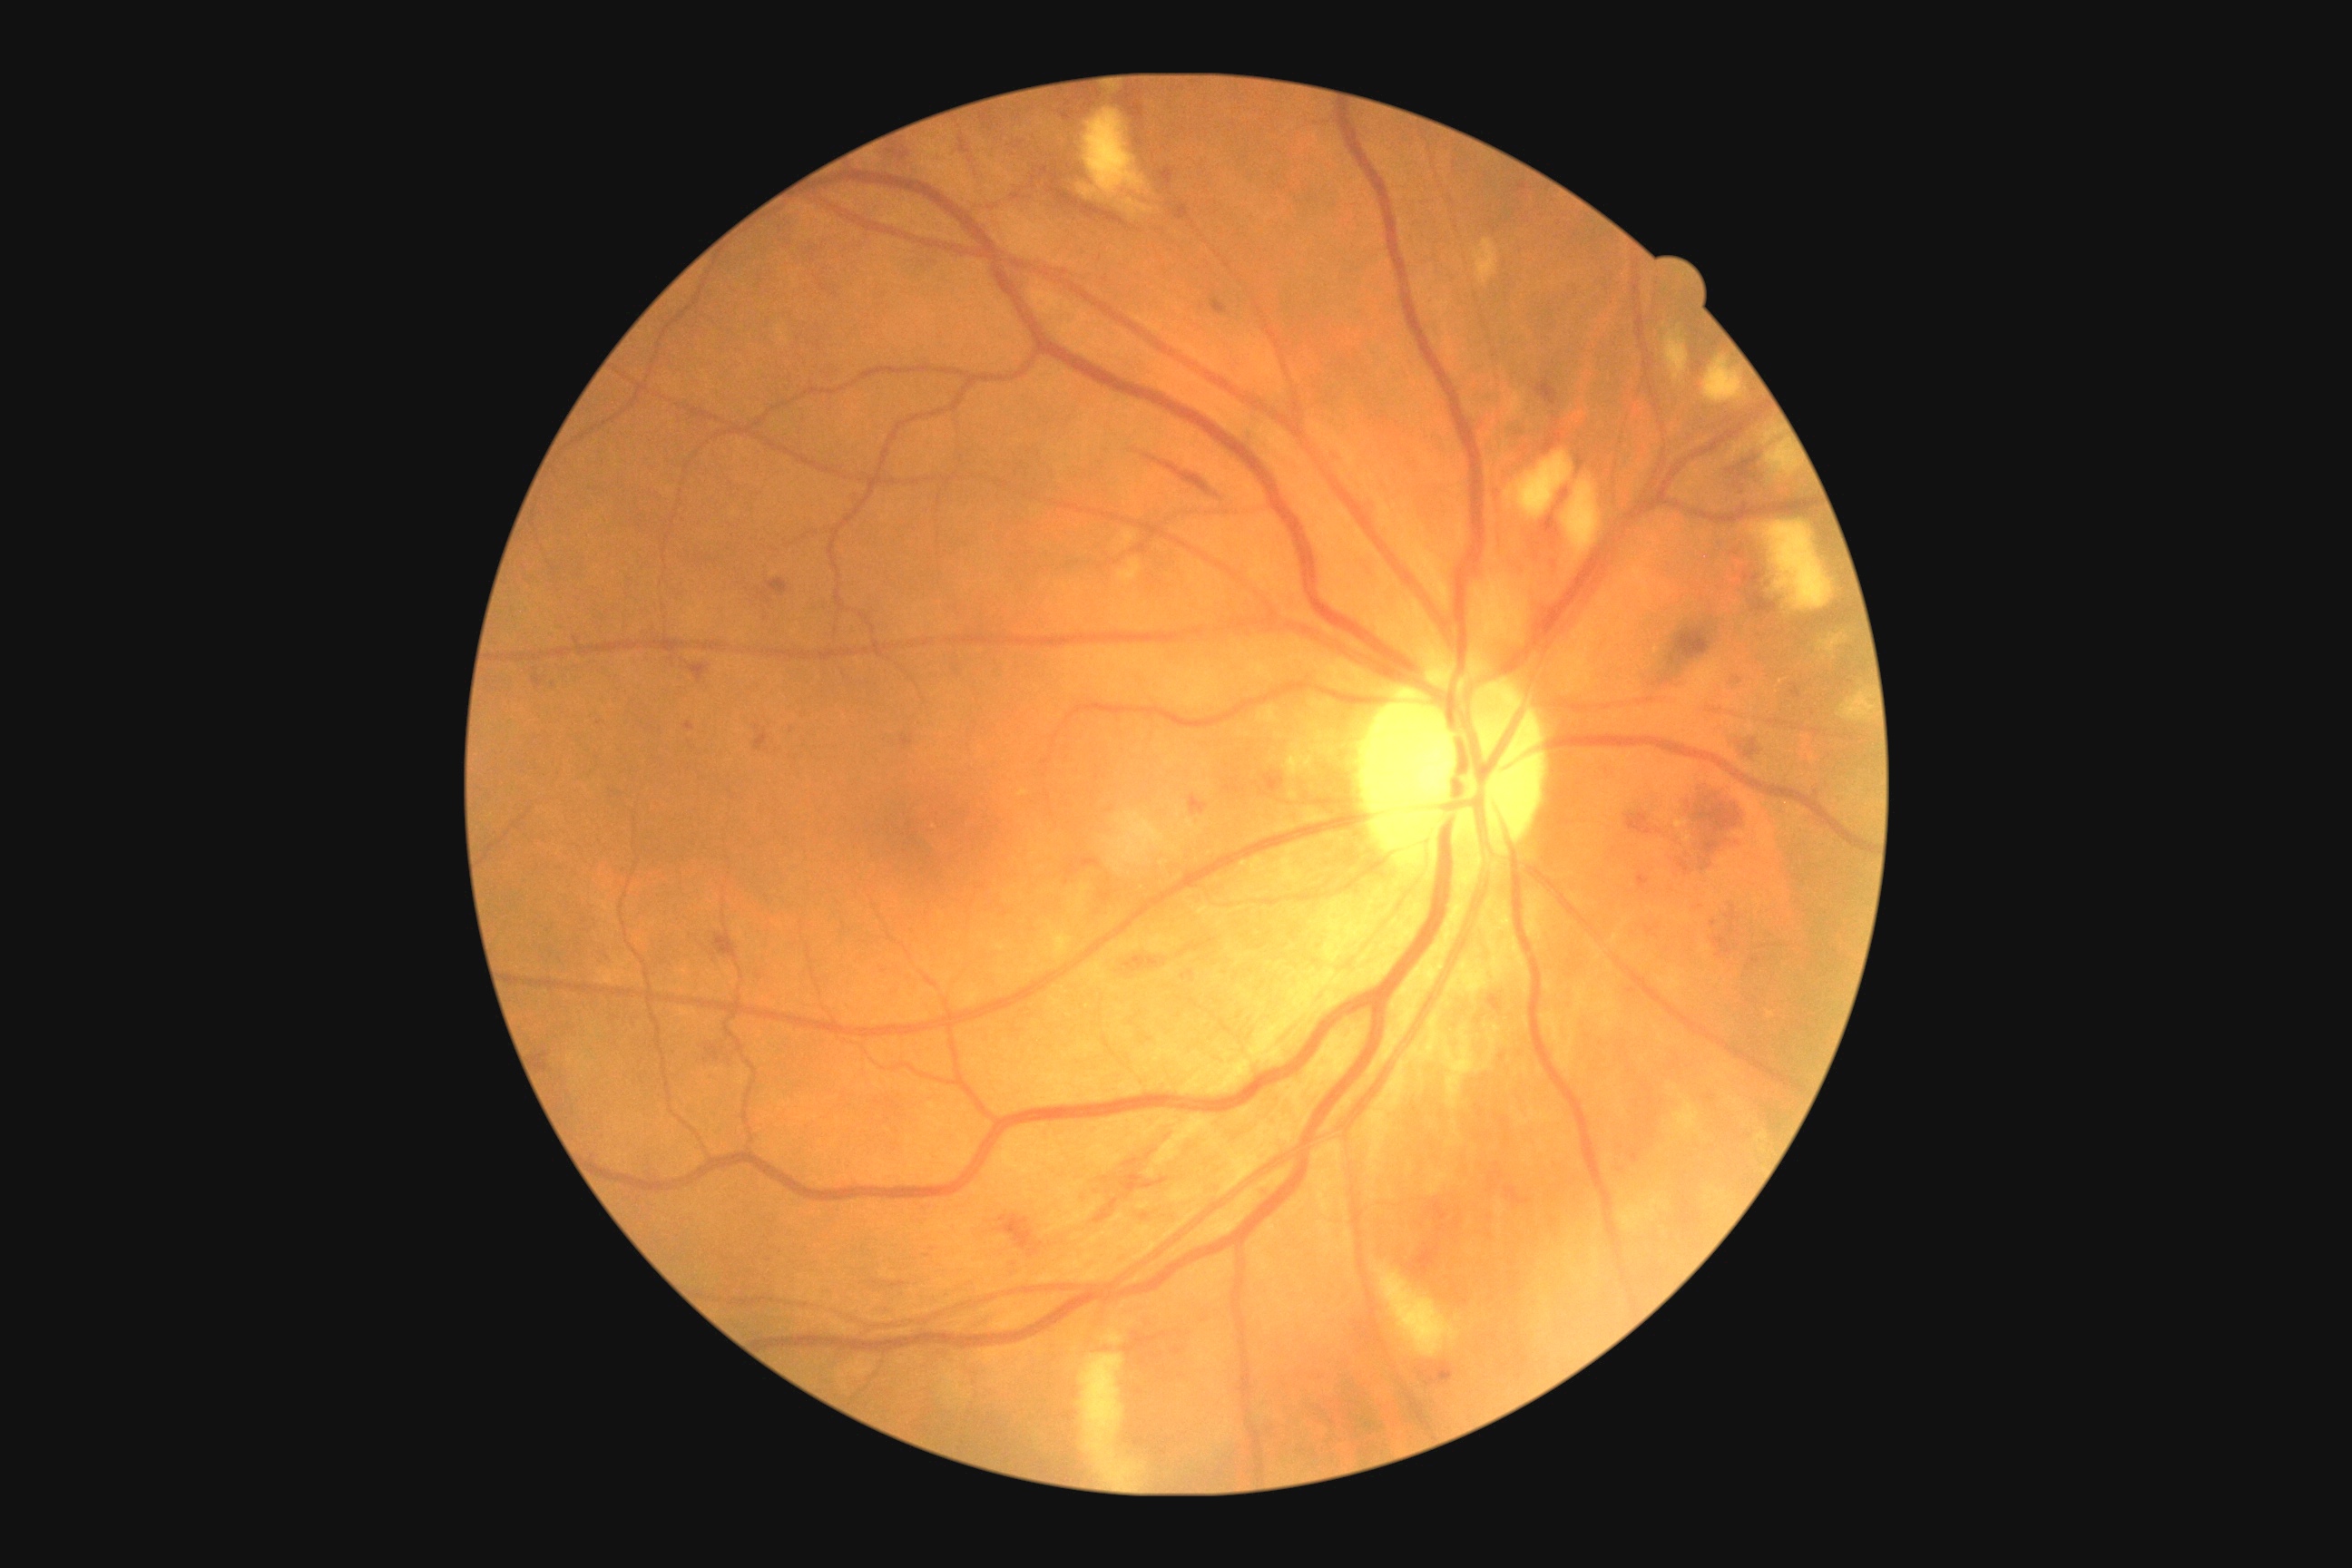

  dr_grade: 2/4
  dr_category: non-proliferative diabetic retinopathy